2228x1652 · fundus photo · 50° field of view · posterior pole field covering the optic disc and macula:
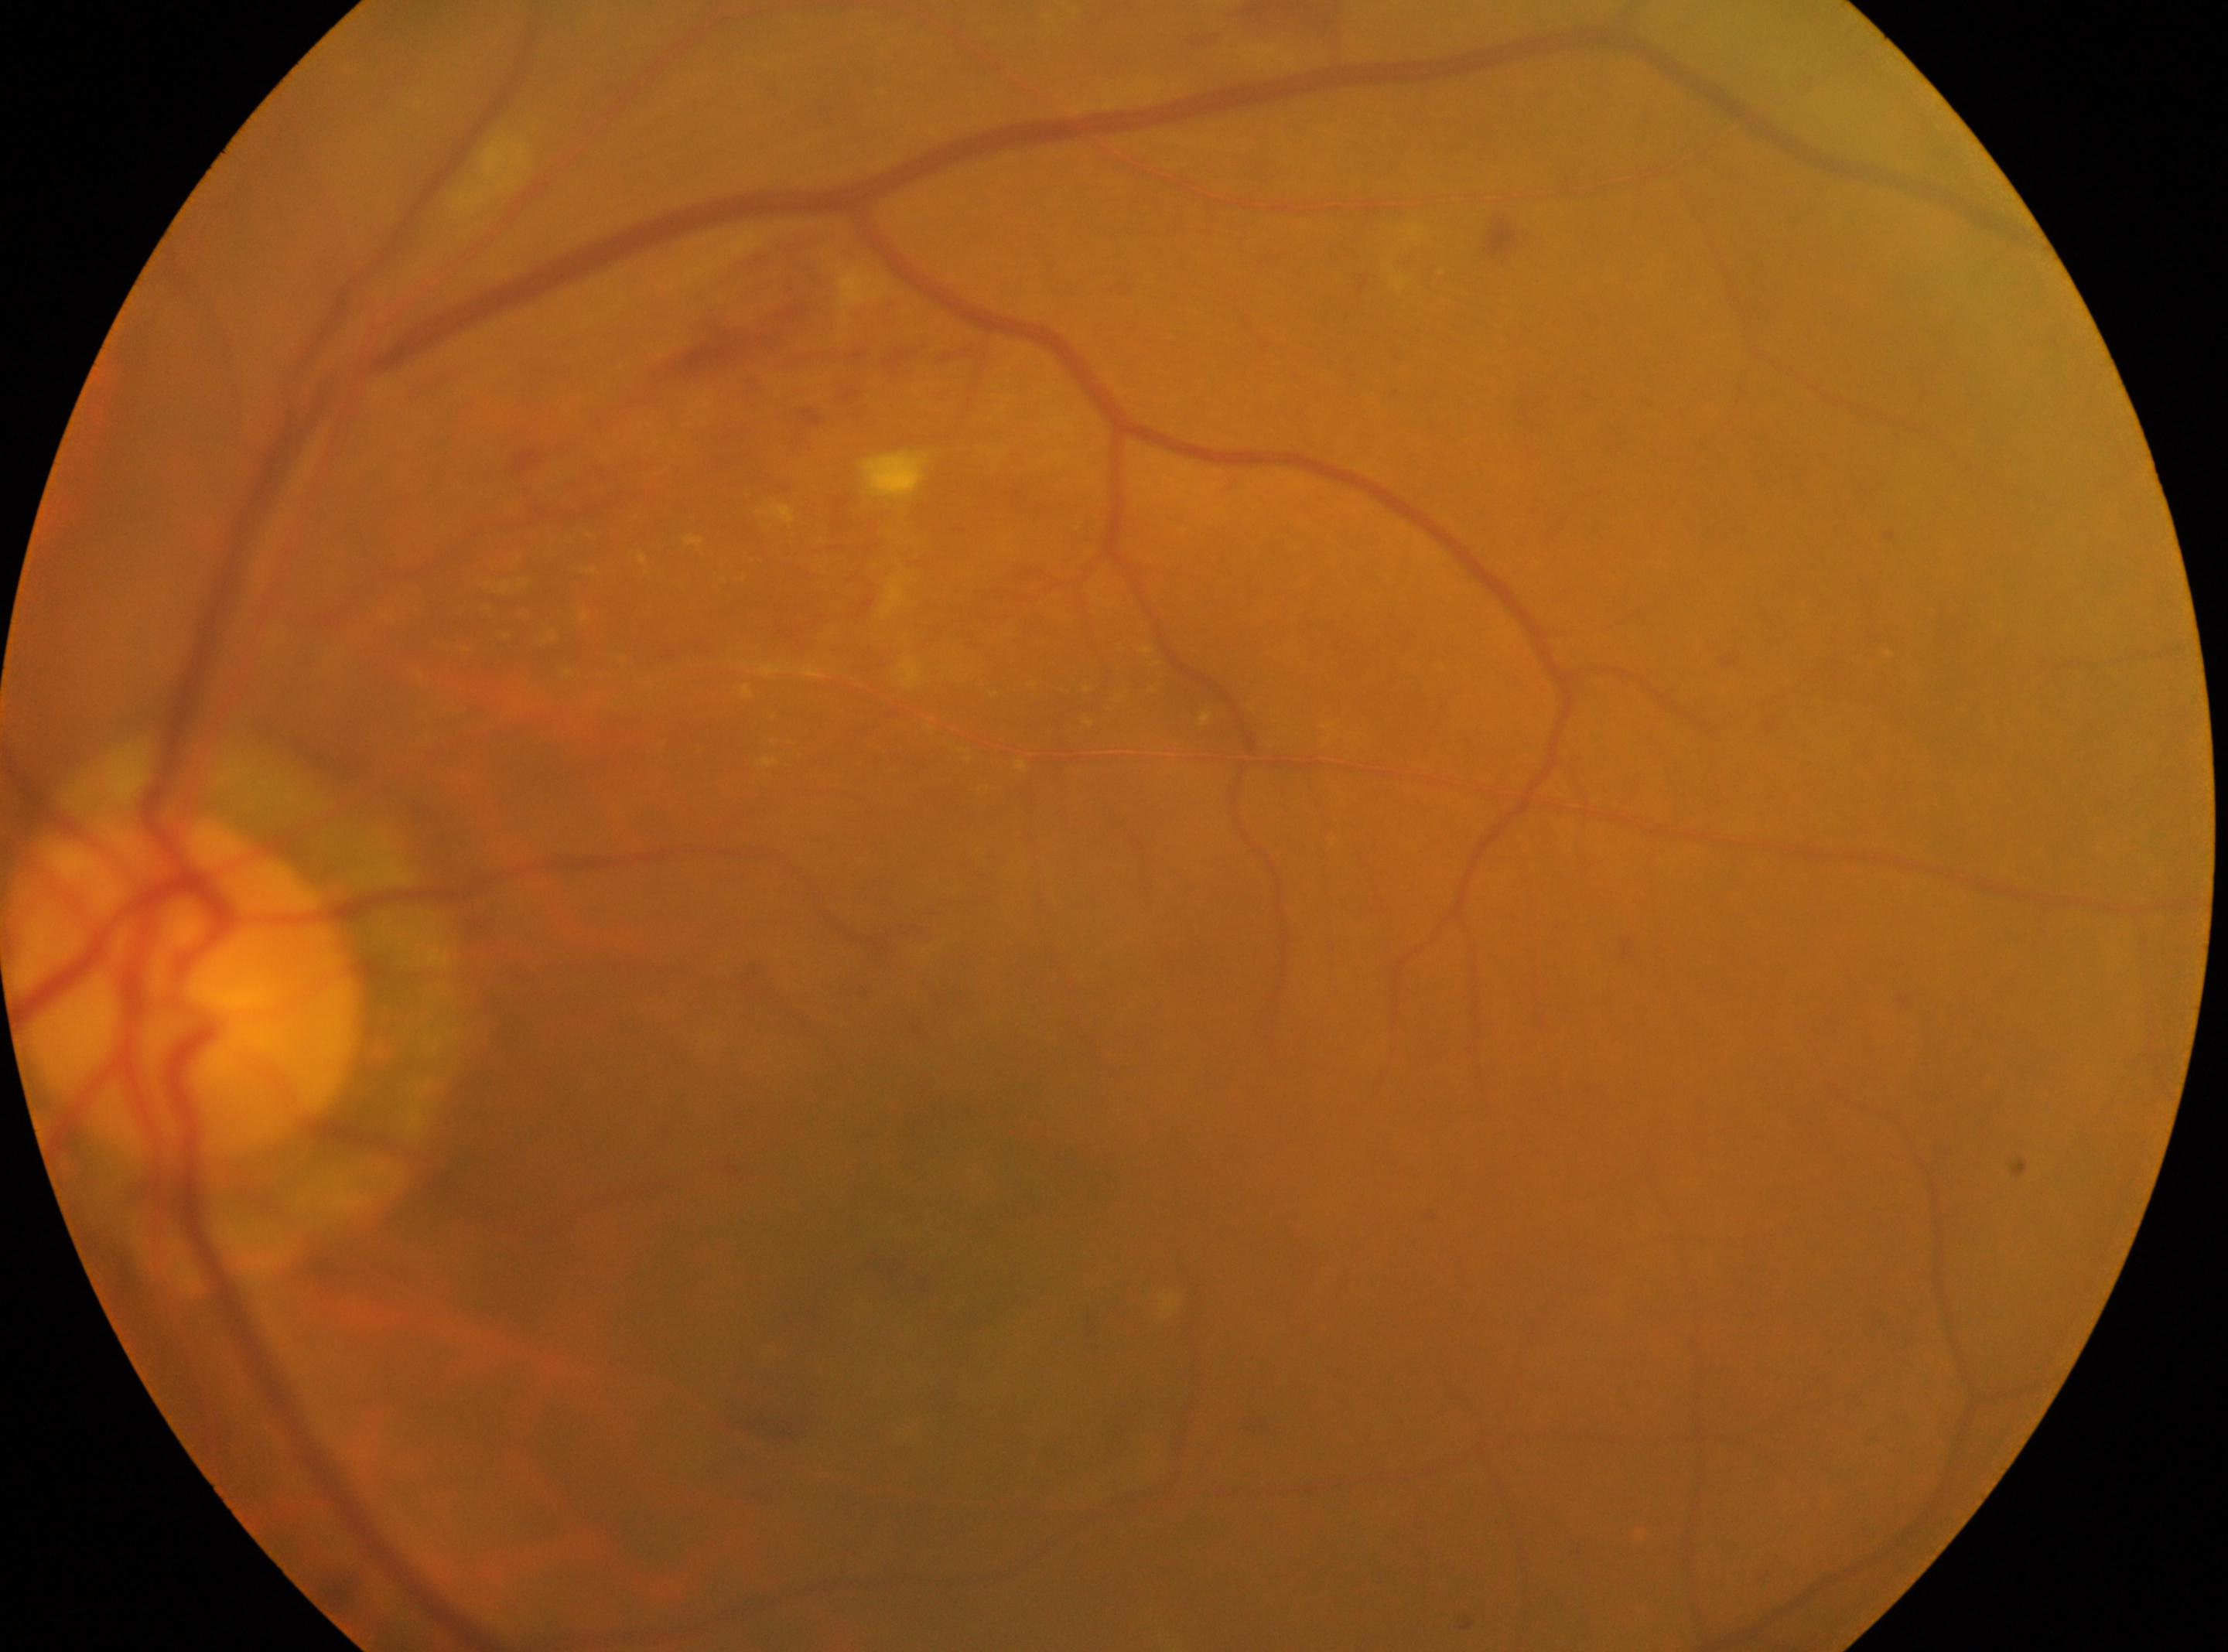
macular center = 935, 1299
diabetic retinopathy severity = grade 2
eye = OS
disc center = 187, 981